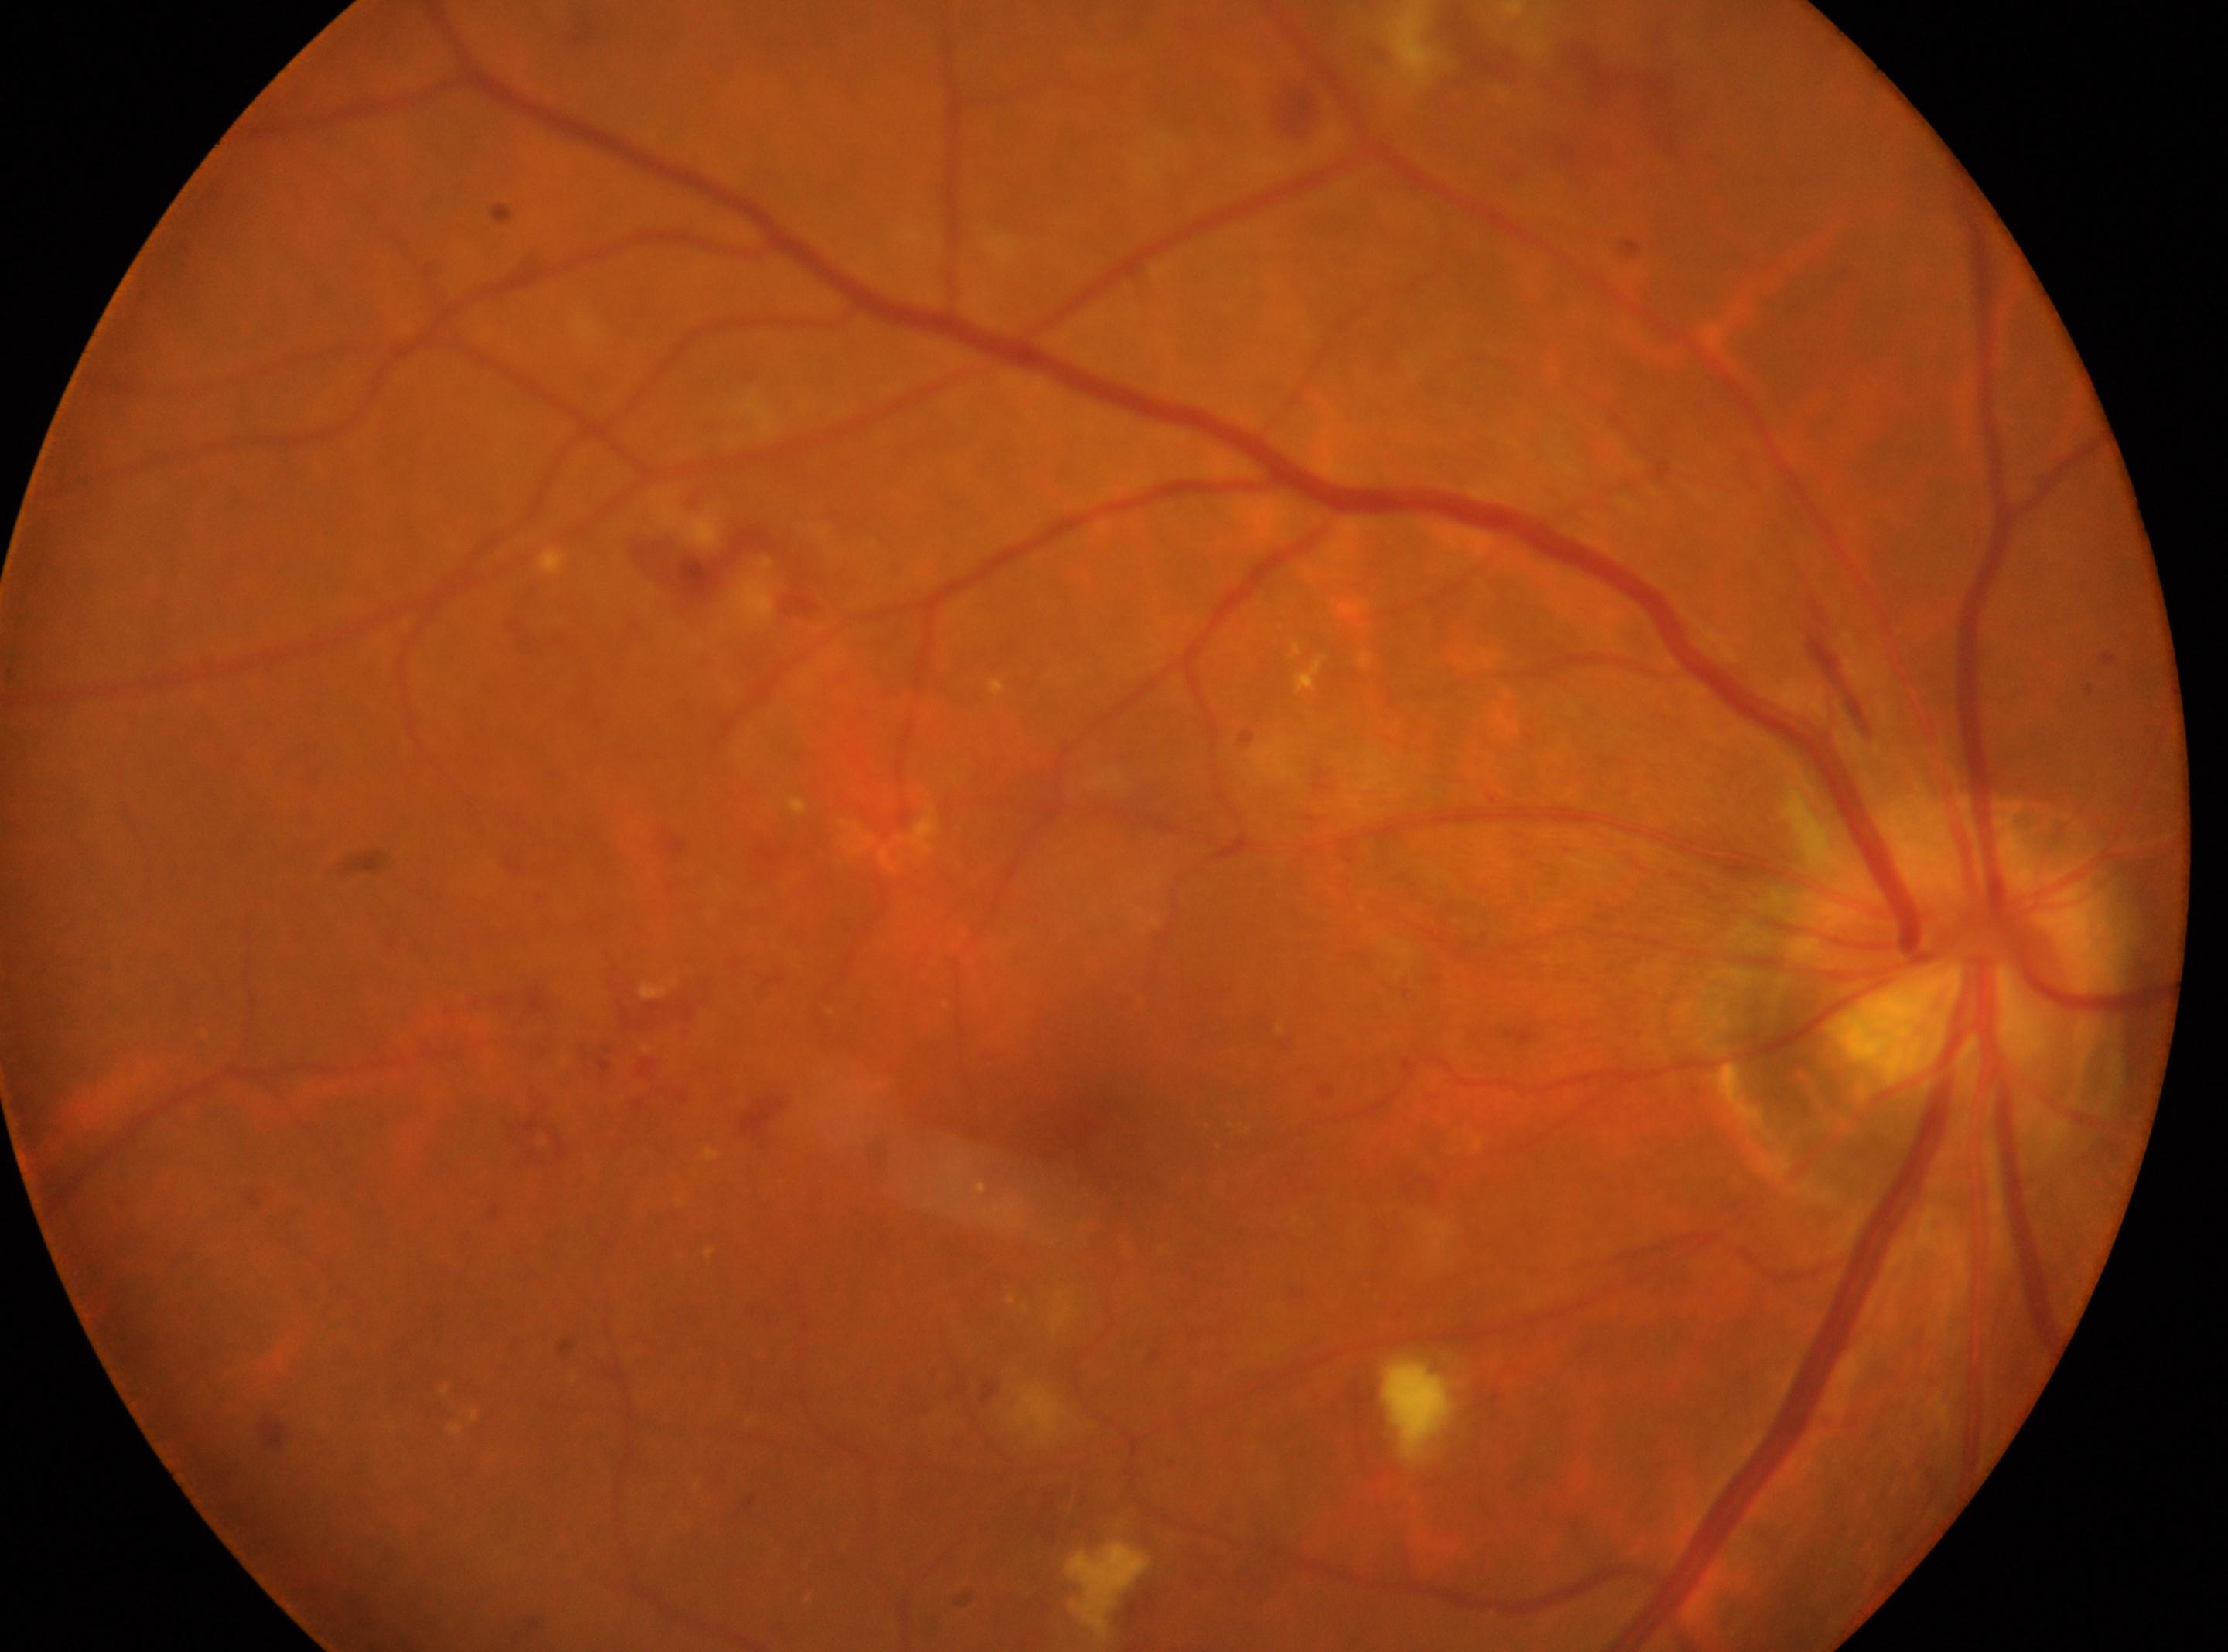
Optic disc: (1946, 986).
Diabetic retinopathy (DR) is grade 2 (moderate NPDR).
Eye: OD.
DR class: non-proliferative diabetic retinopathy.
The fovea centralis is at (1092, 1126).